Nonmydriatic fundus photograph — 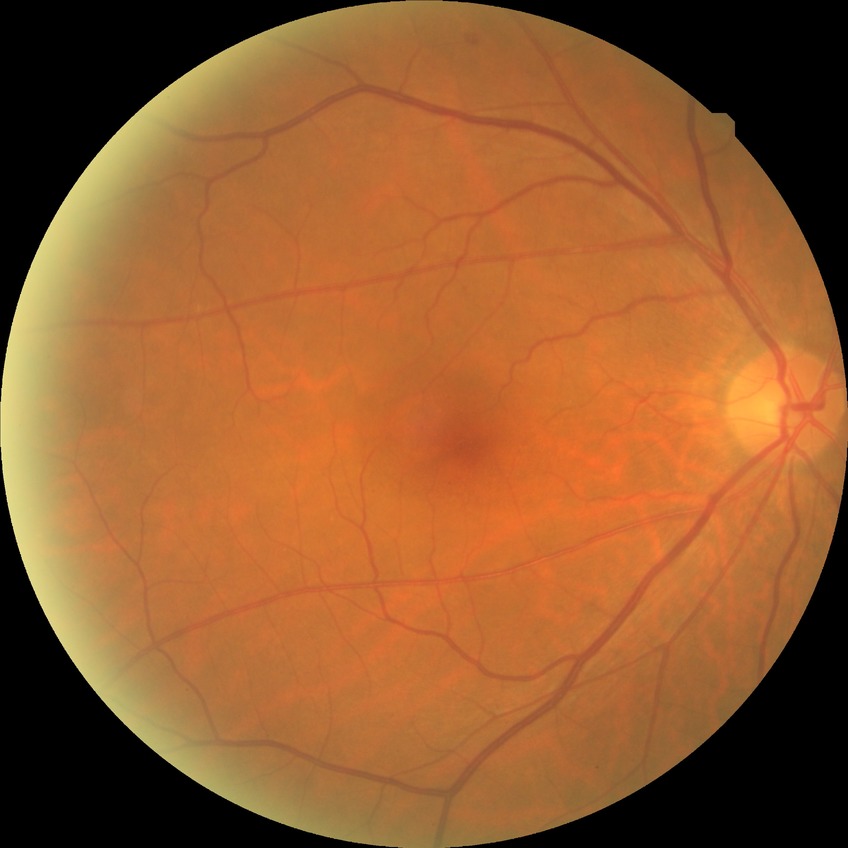 {
  "davis_grade": "NDR"
}